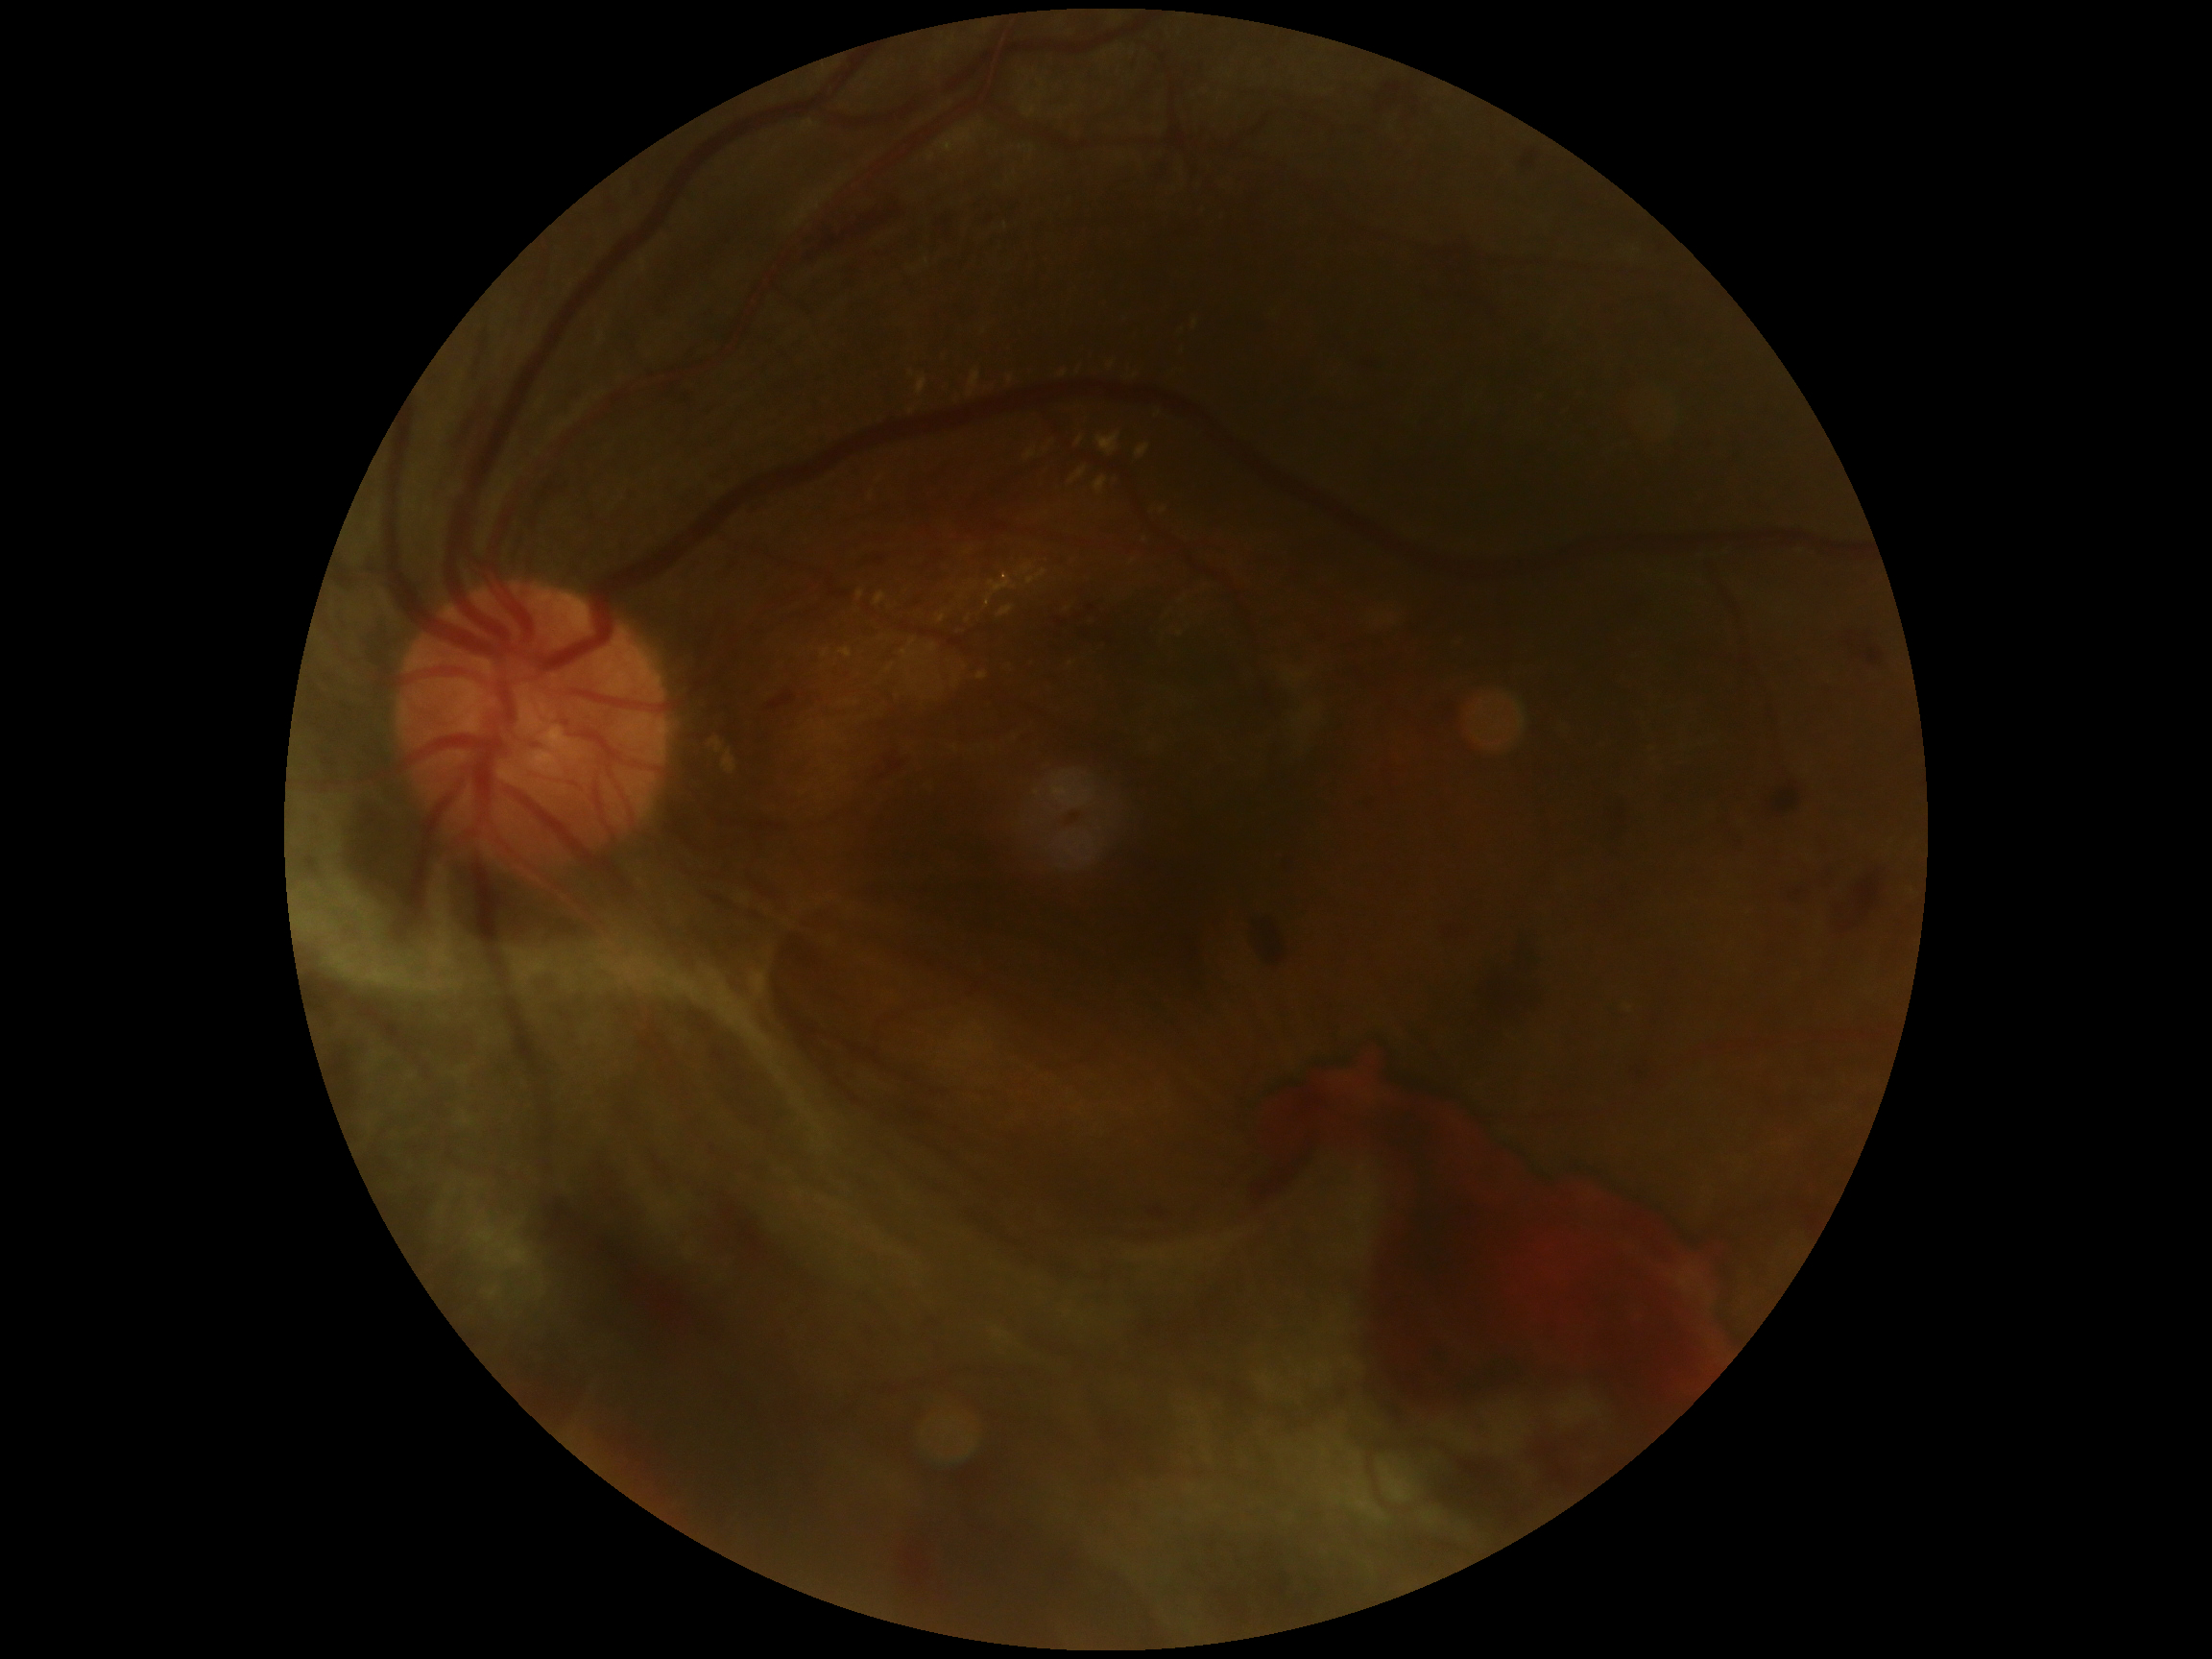

Diabetic retinopathy (DR) is grade 4.